FOV: 45 degrees:
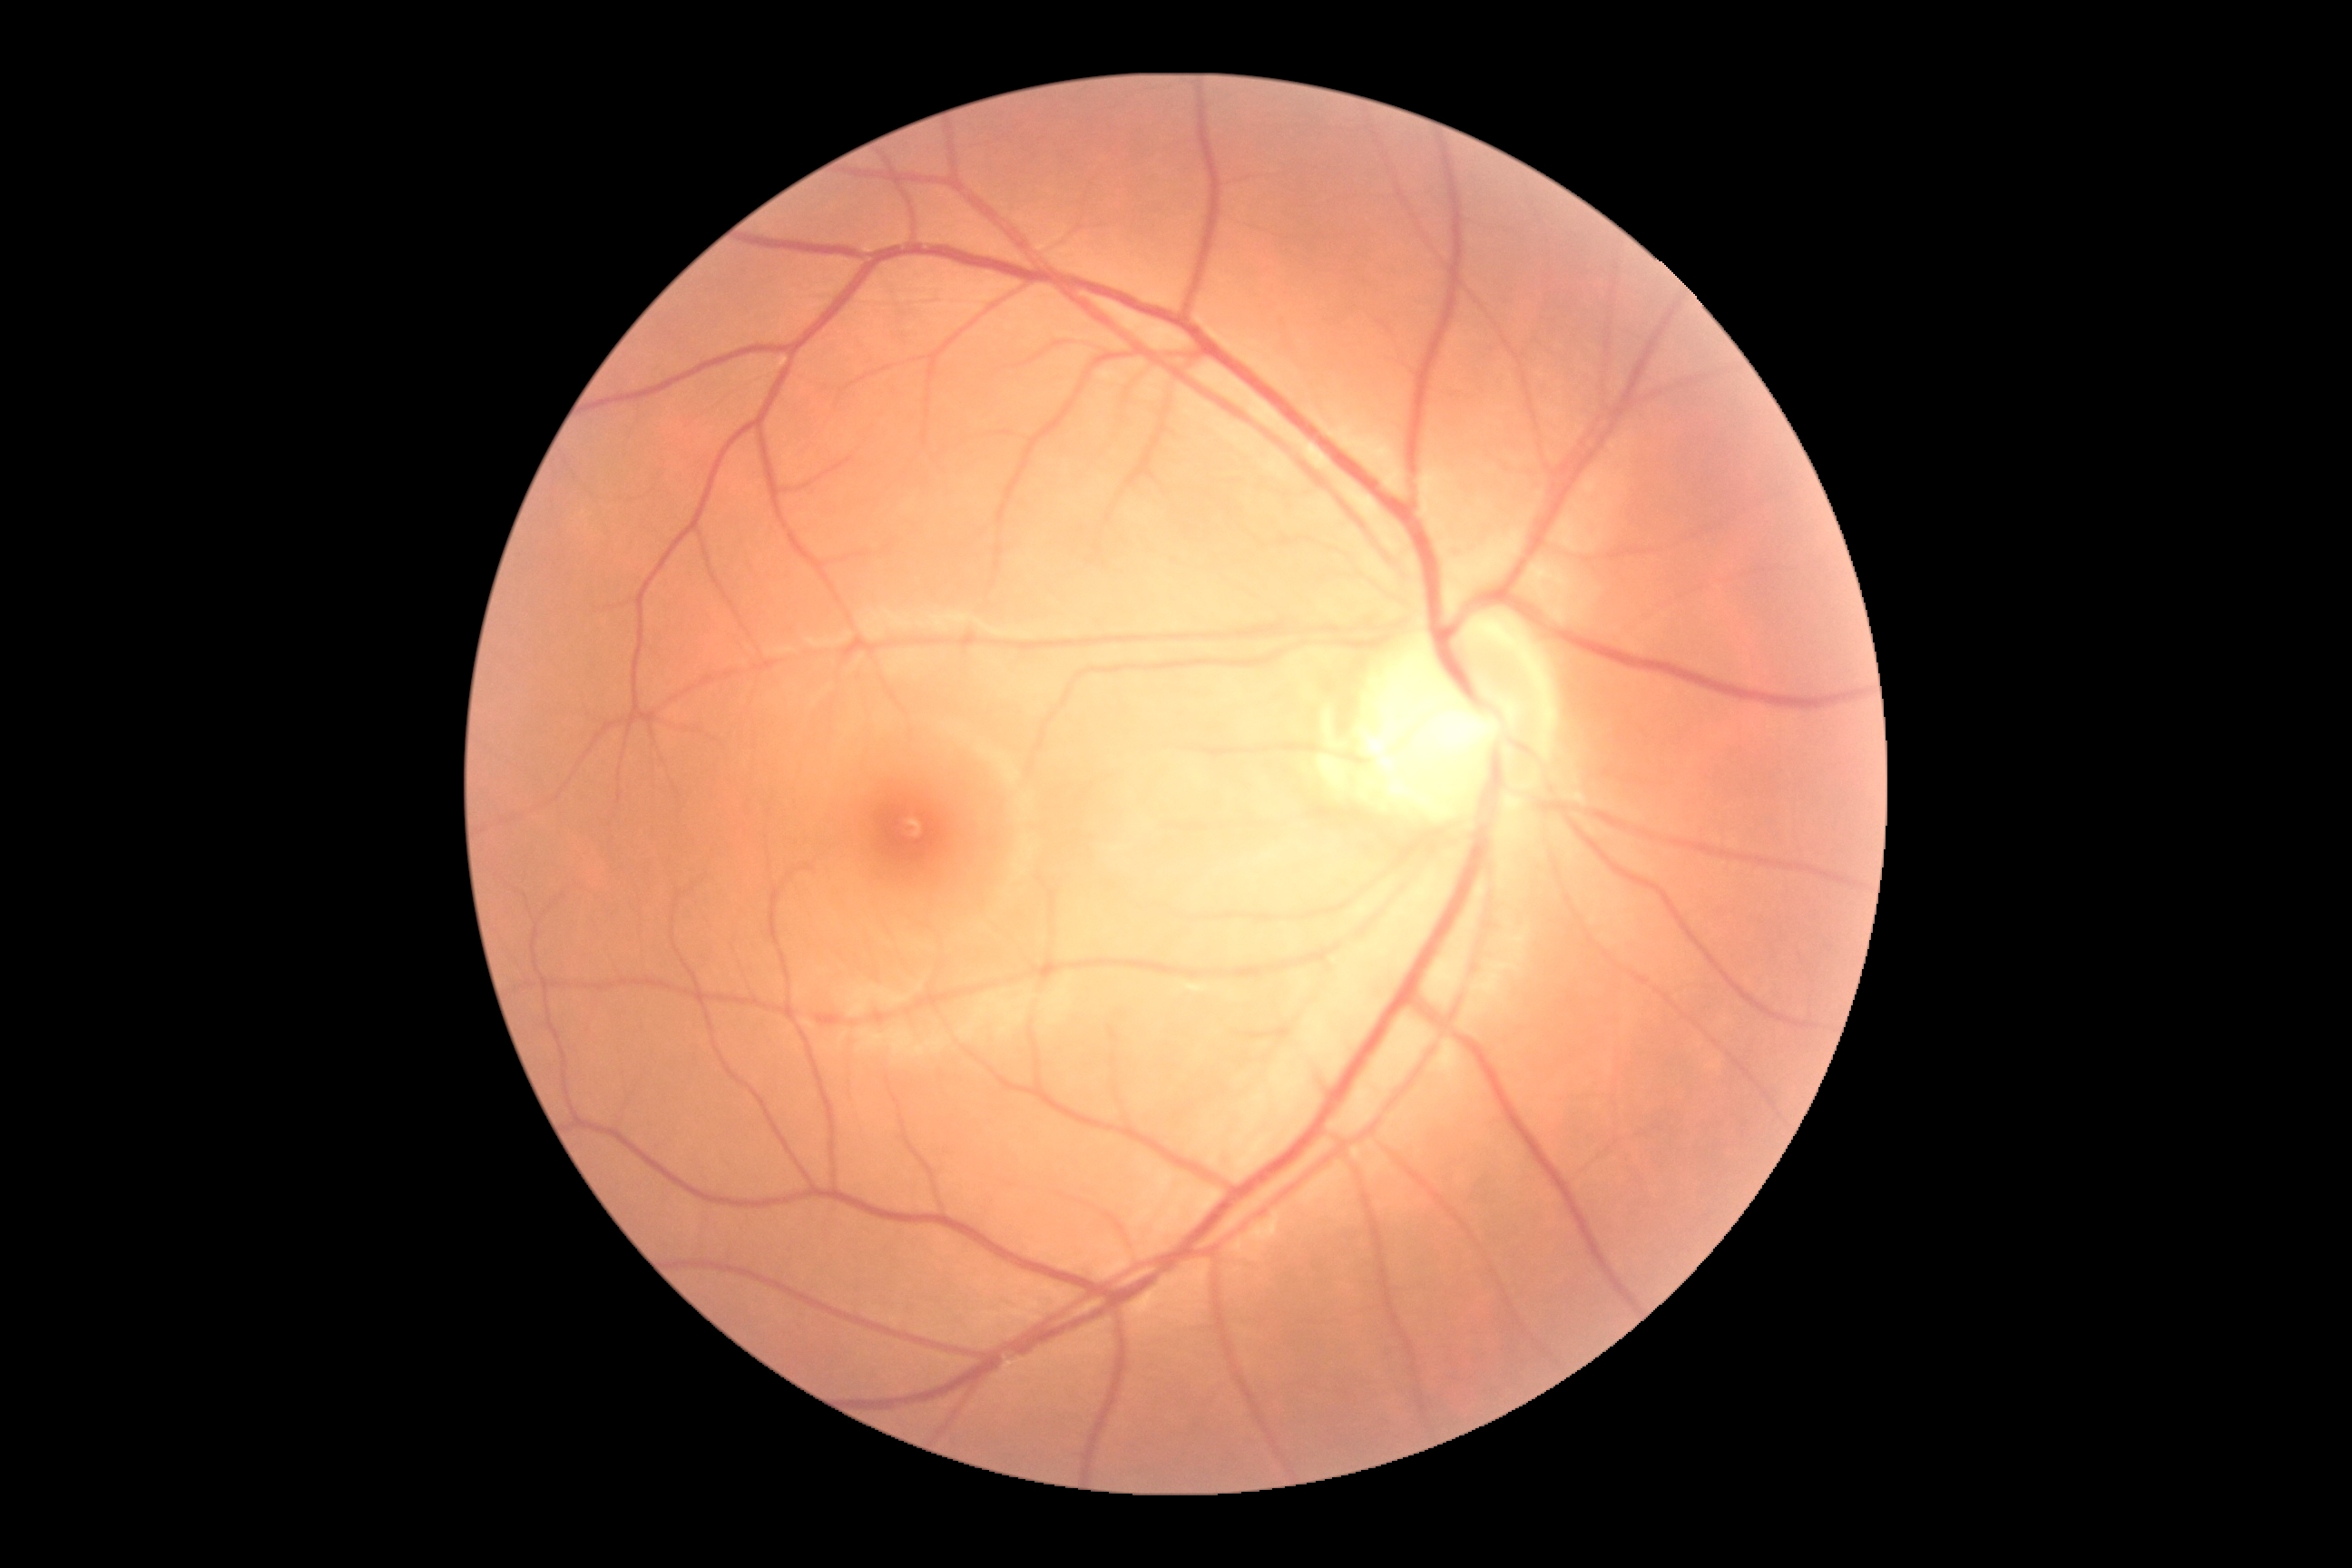

DR: grade 0 (no apparent retinopathy). No diabetic retinal disease findings.